45° field of view
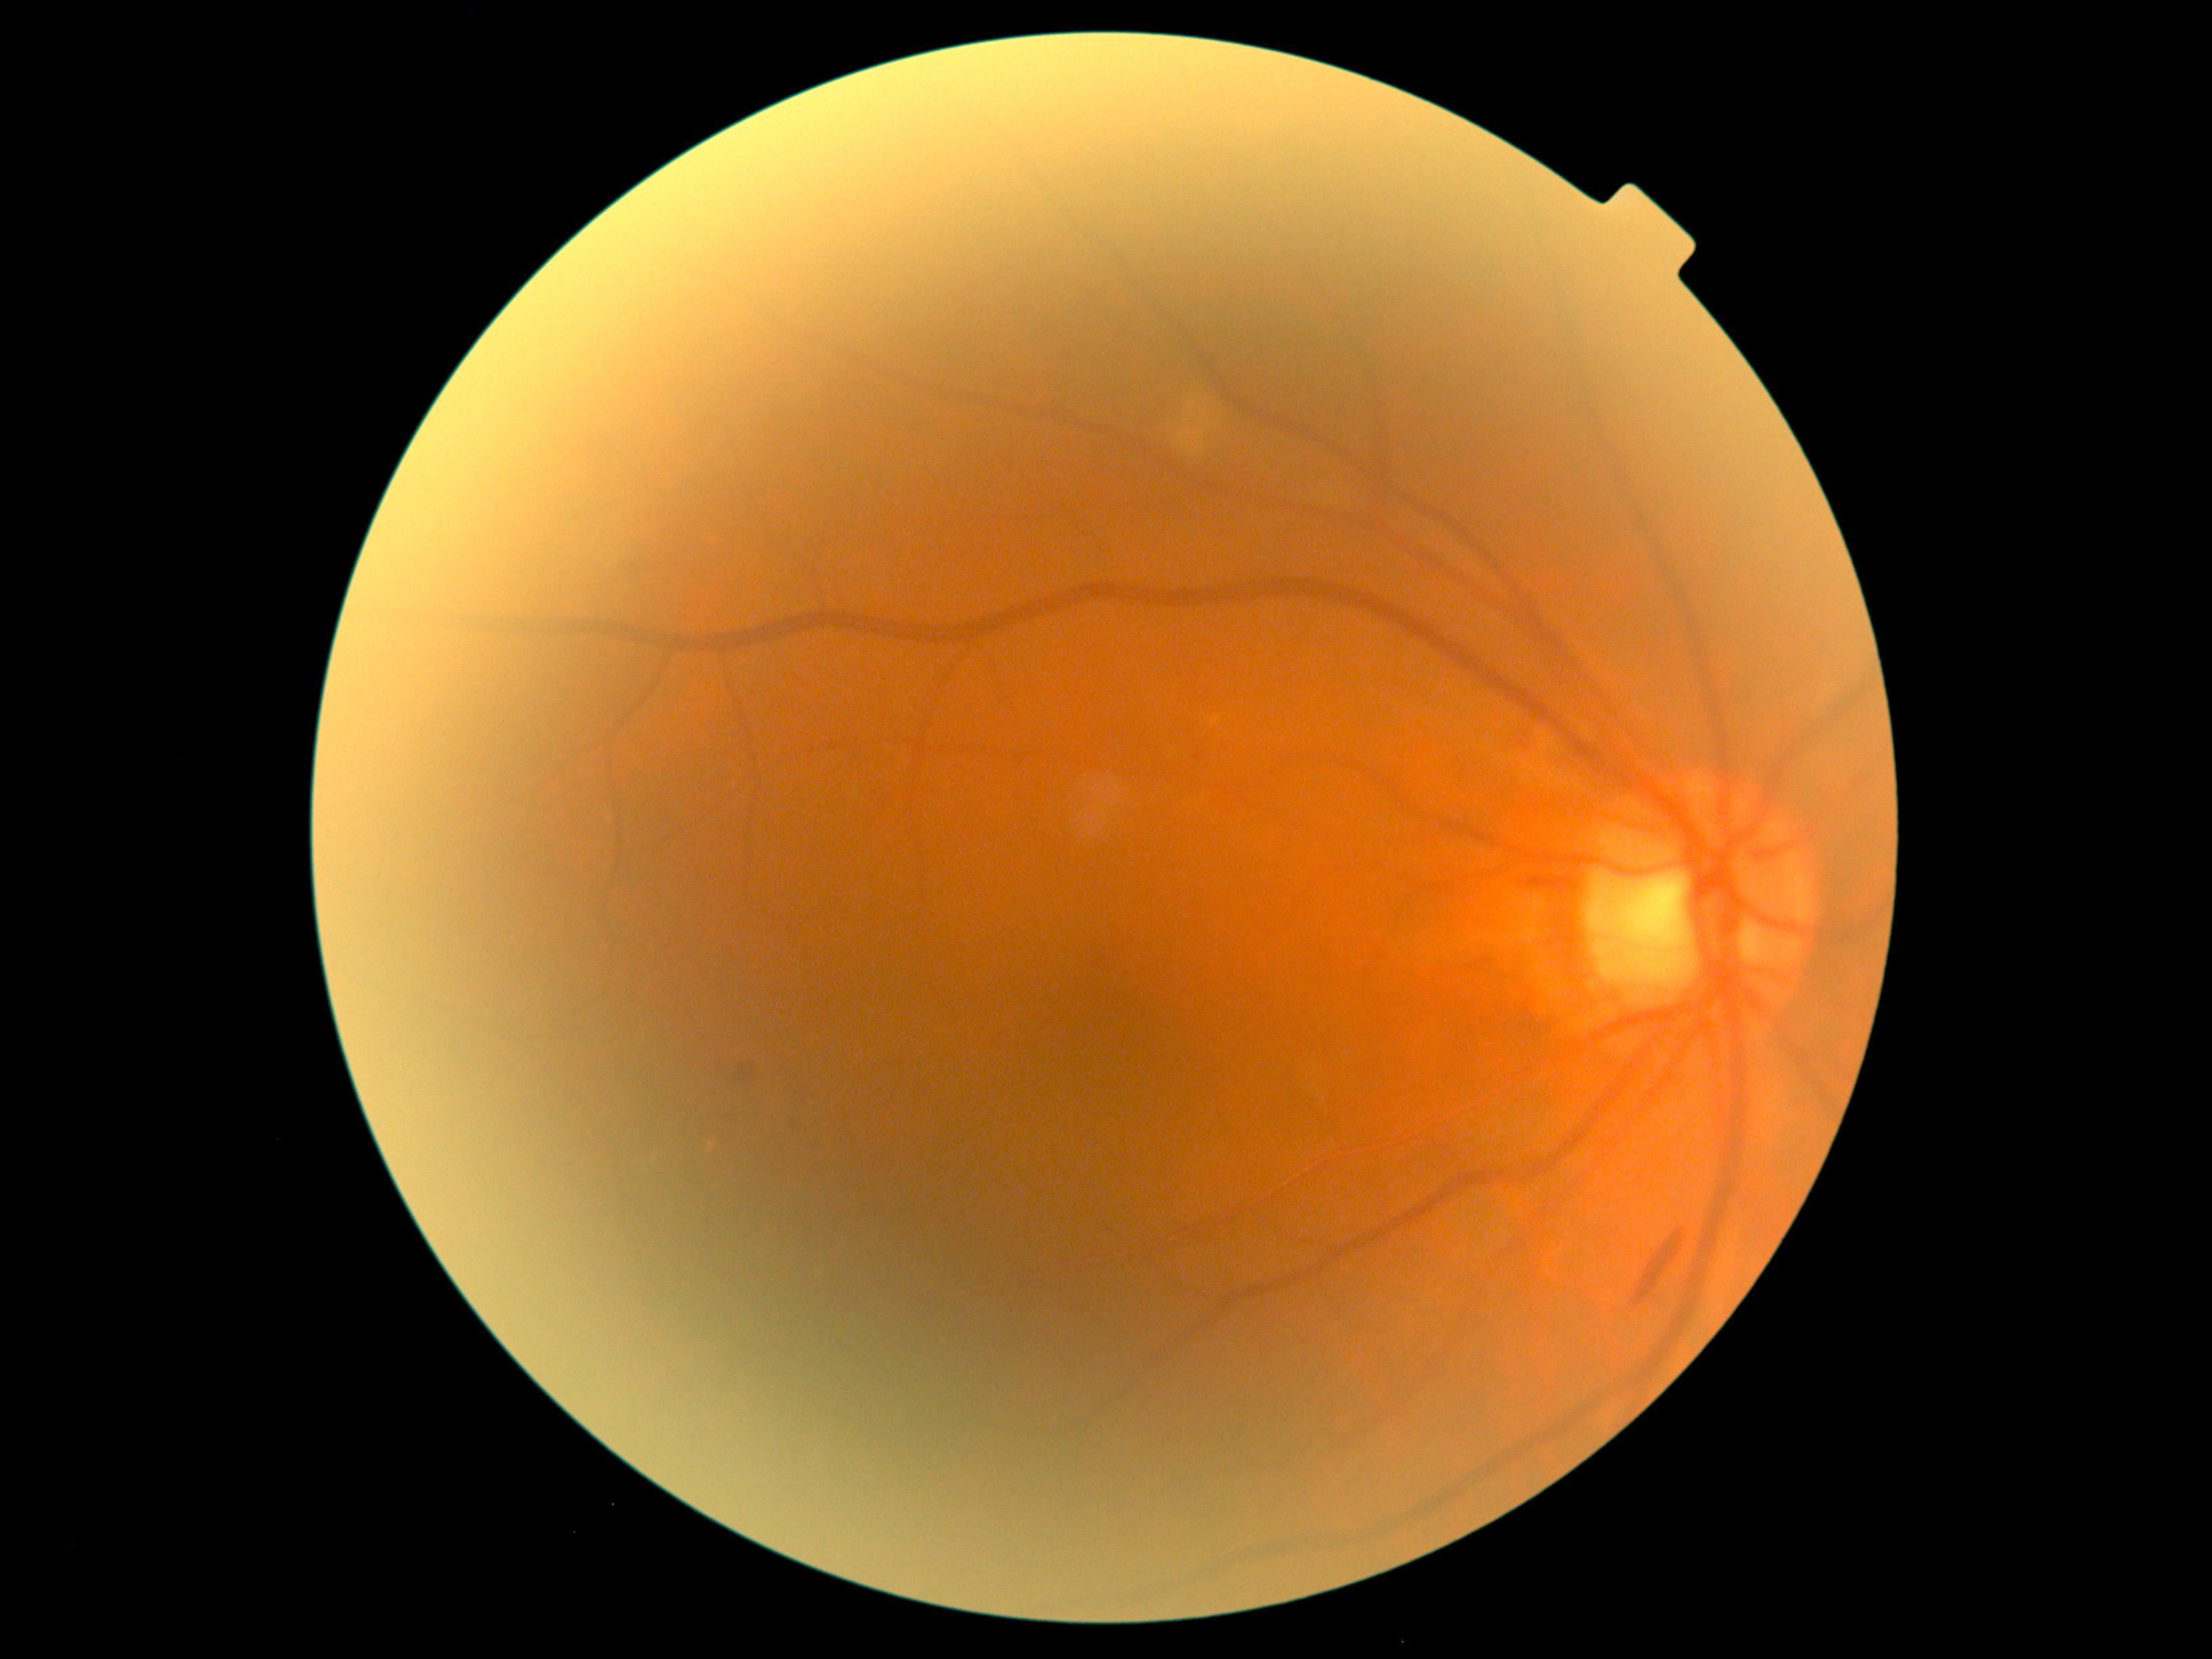 DR grade: 2. Disease class: non-proliferative diabetic retinopathy.